2352x1568px. Fundus photo — 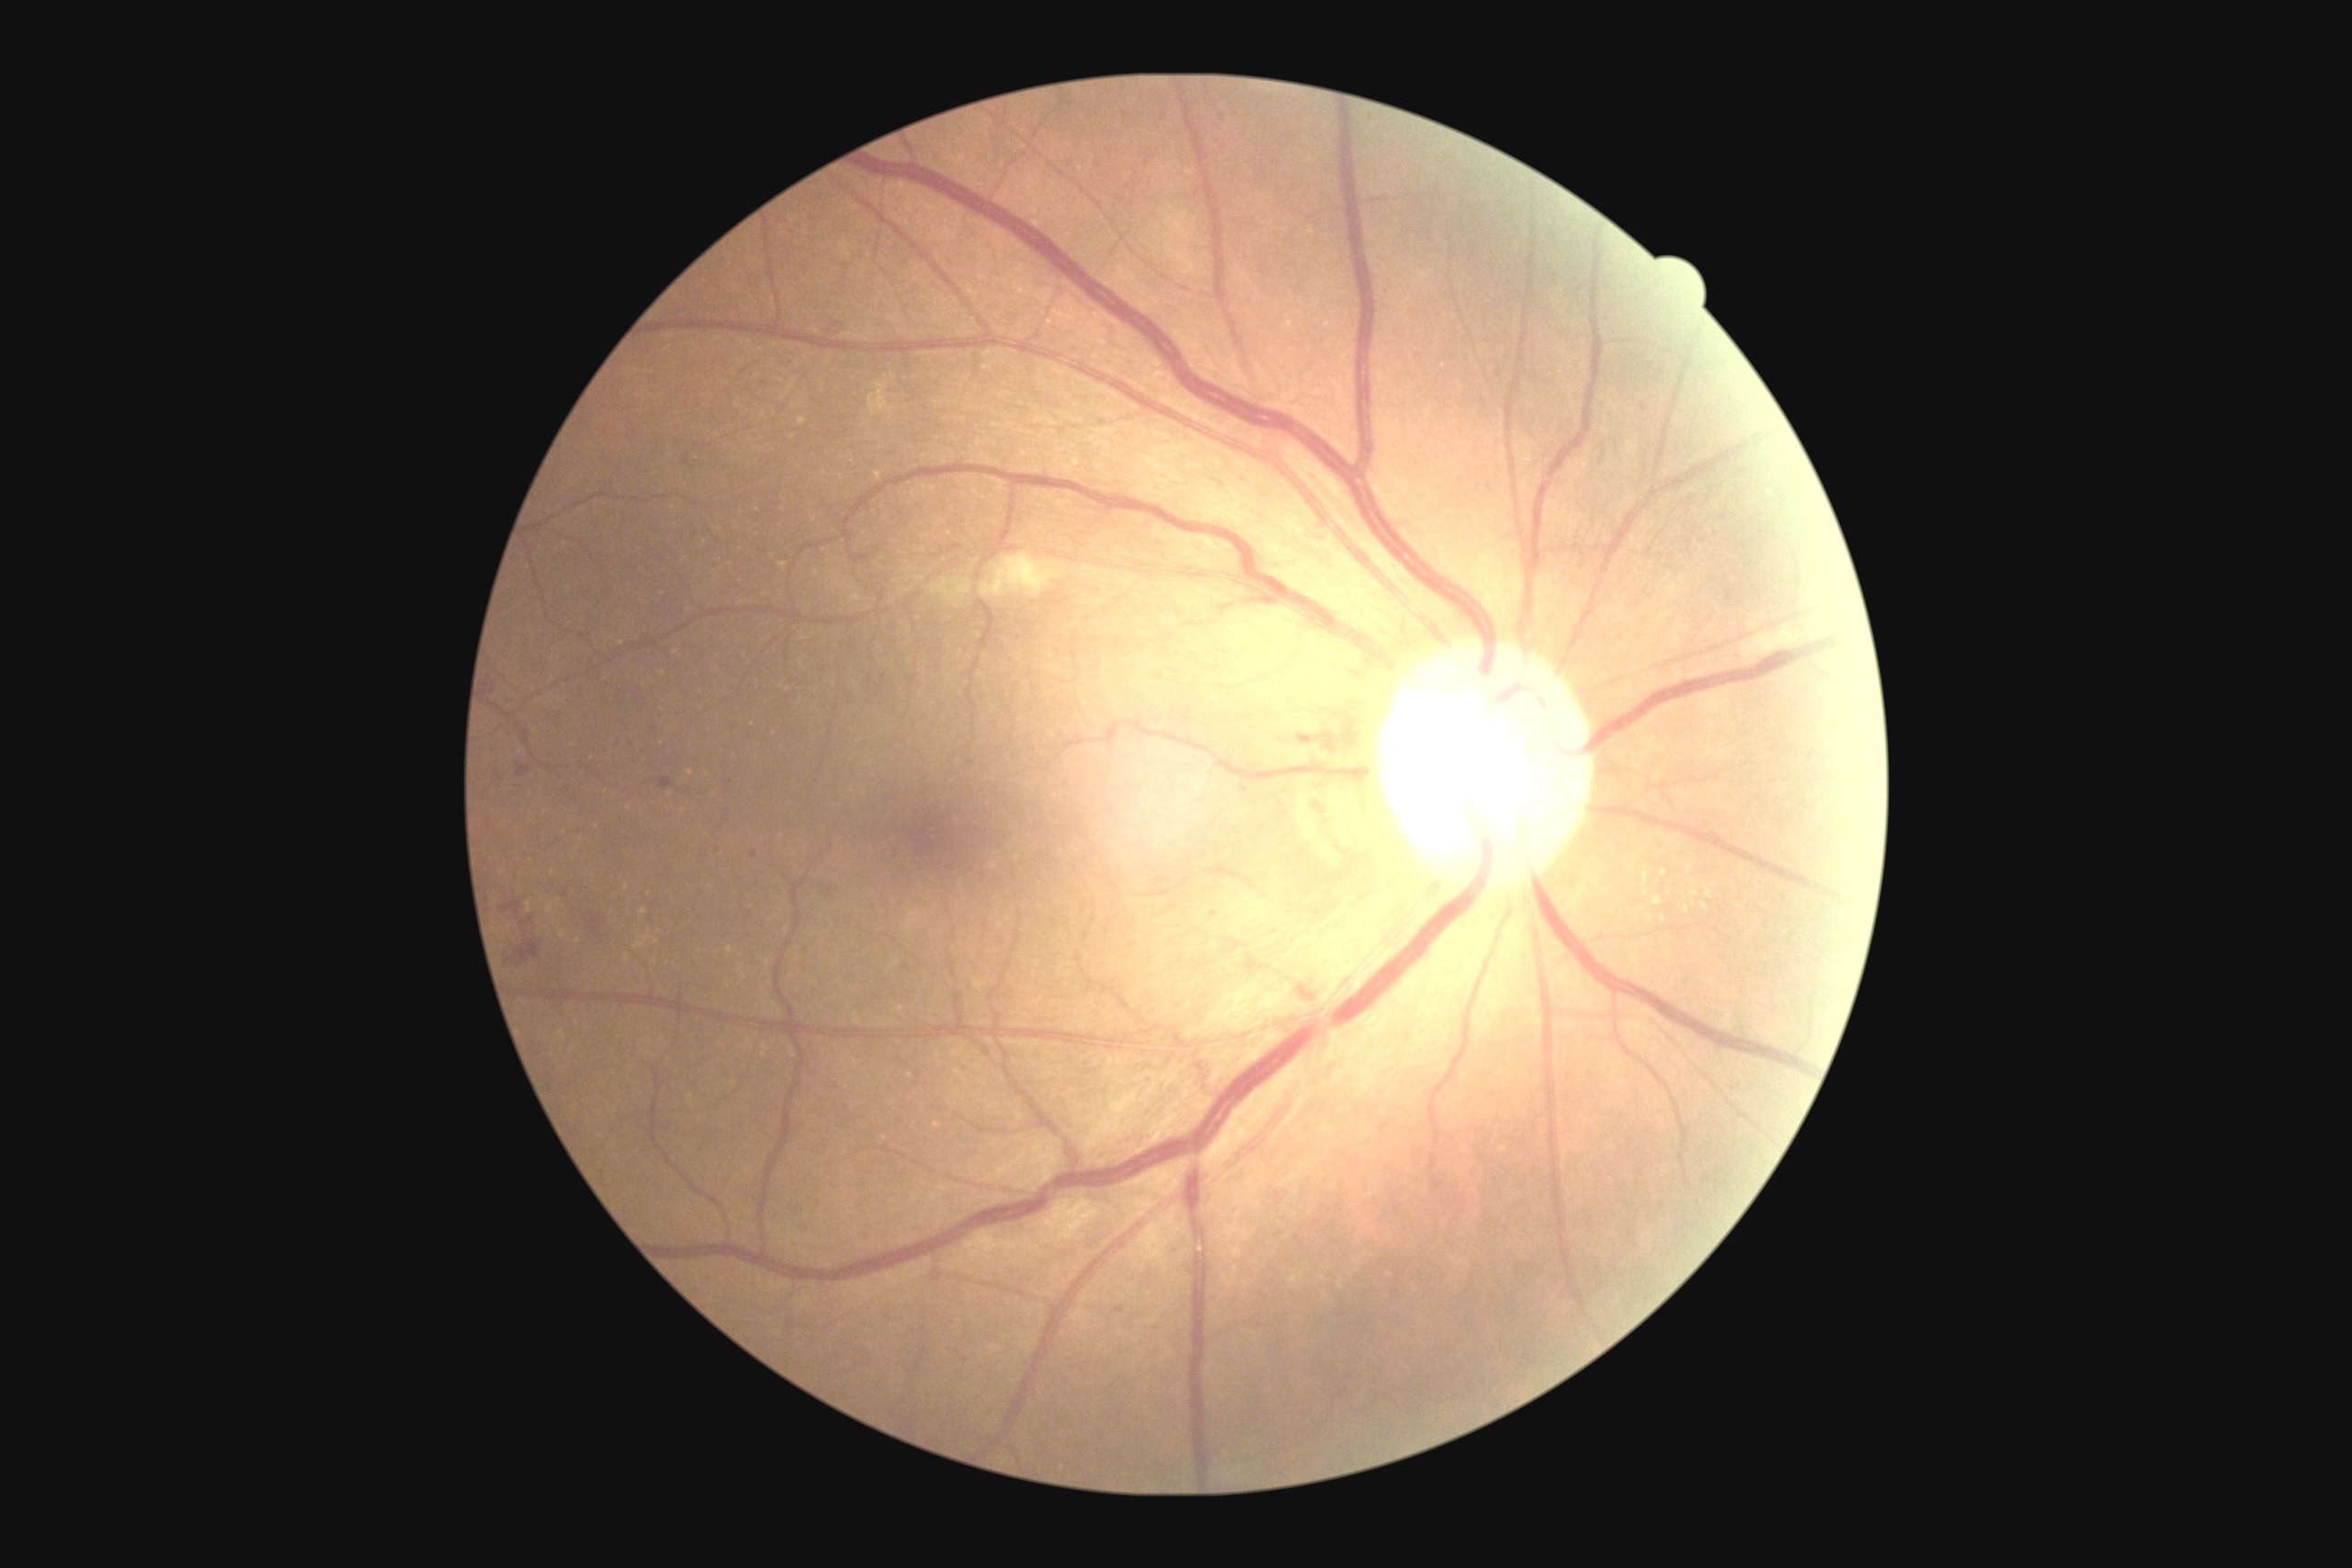
Diabetic retinopathy severity is grade 2 (moderate NPDR)
Representative lesions:
* microaneurysms (more not shown): 1170/1248/1181/1257 | 631/741/636/749 | 487/681/495/696 | 1320/736/1338/750 | 520/917/534/928 | 827/887/836/894 | 504/903/520/914 | 516/765/531/778 | 1113/1308/1124/1315
* Small microaneurysms approximately at {"x": 565, "y": 895} | {"x": 953, "y": 869} | {"x": 1734, "y": 1090} | {"x": 609, "y": 753} | {"x": 1490, "y": 487}